Color fundus photograph · 2352 x 1568 pixels — 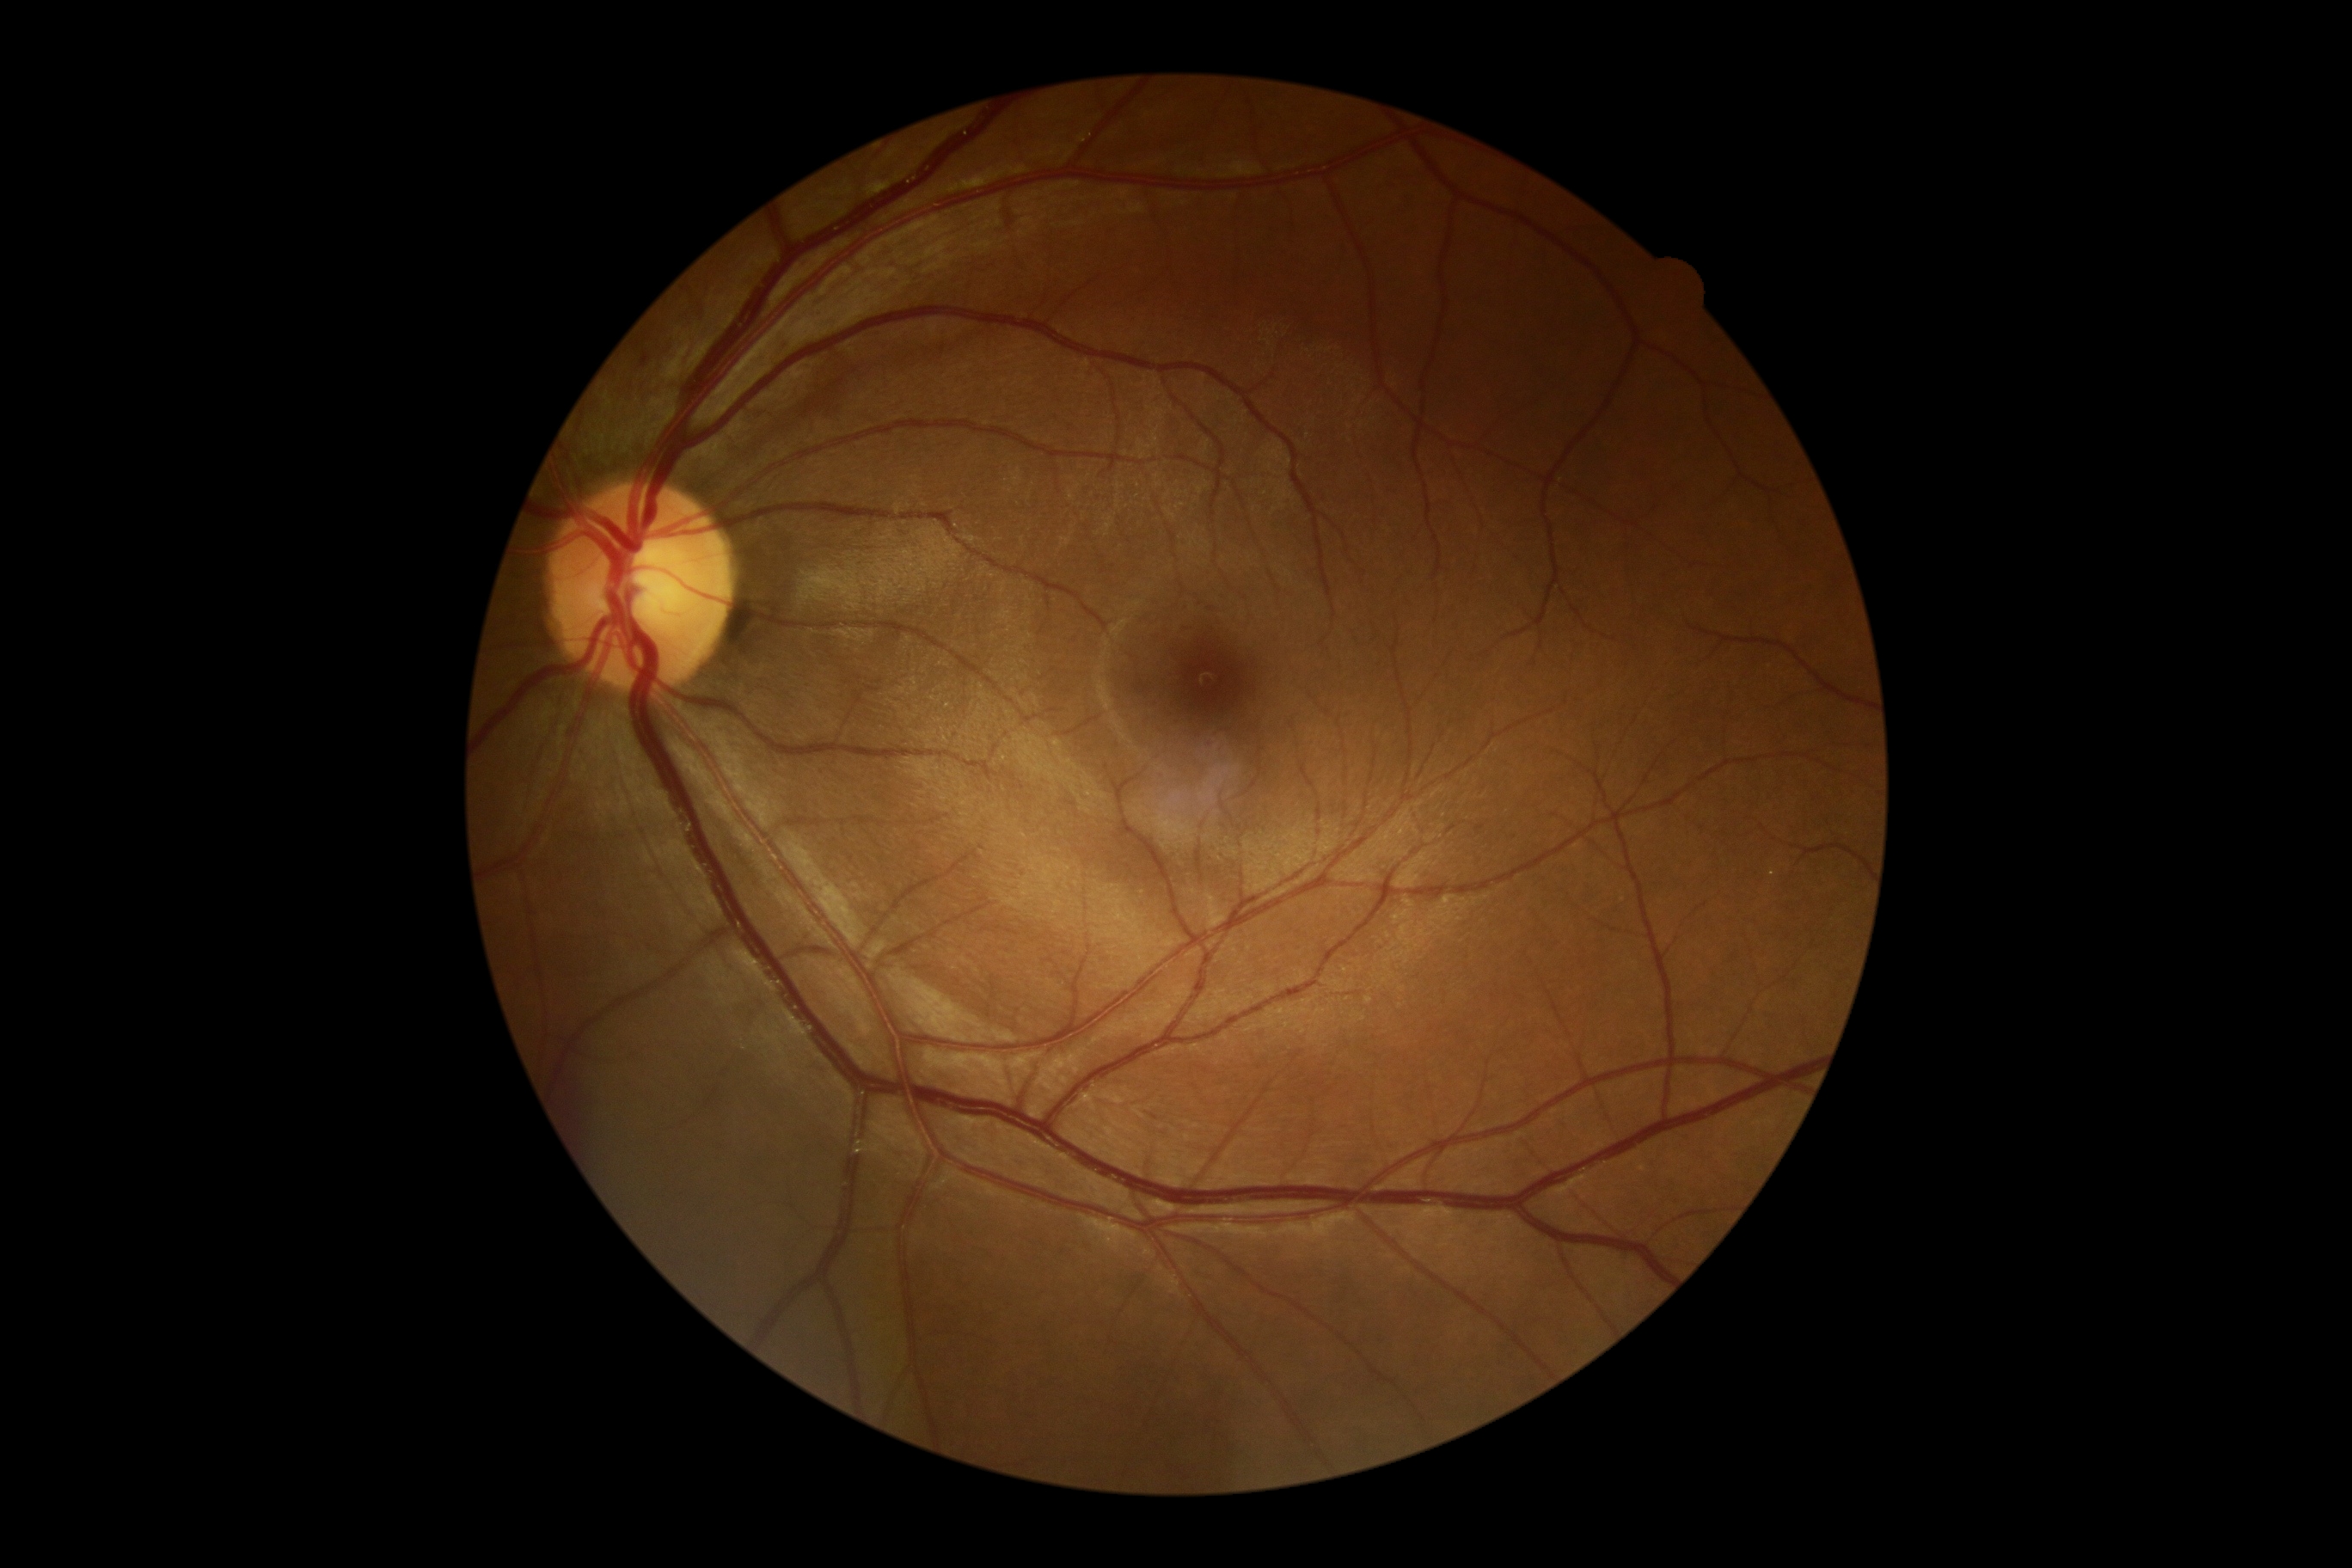
No signs of diabetic retinopathy. Retinopathy grade: 0.